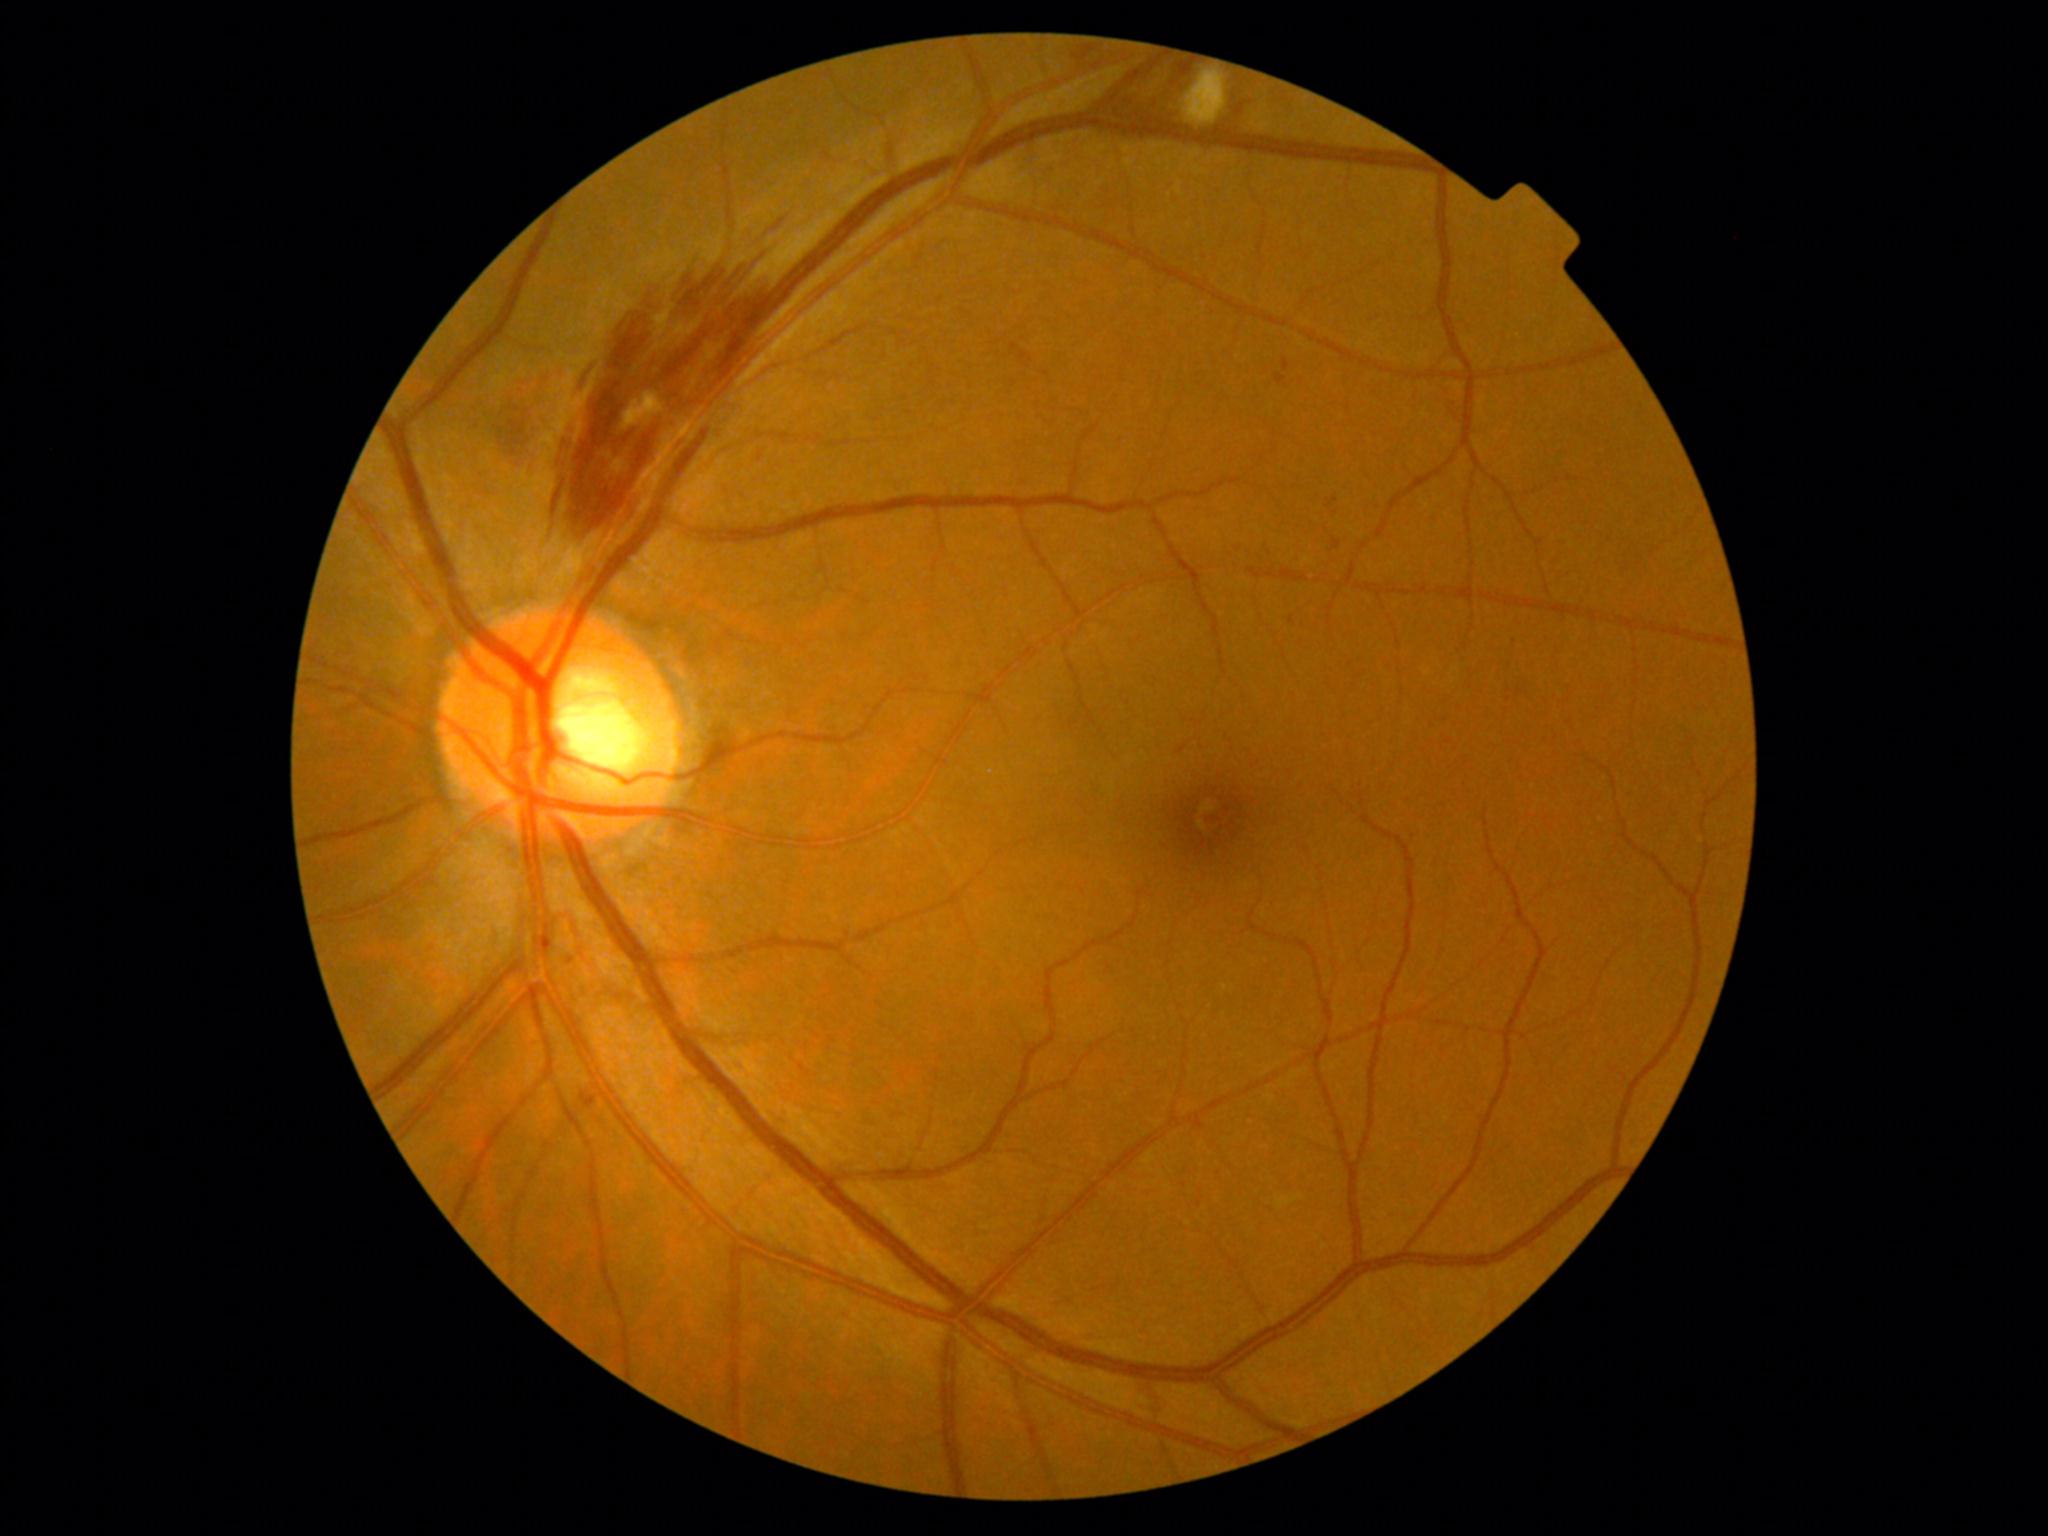
diabetic retinopathy (DR) = grade 2 (moderate NPDR).